2212 by 1659 pixels.
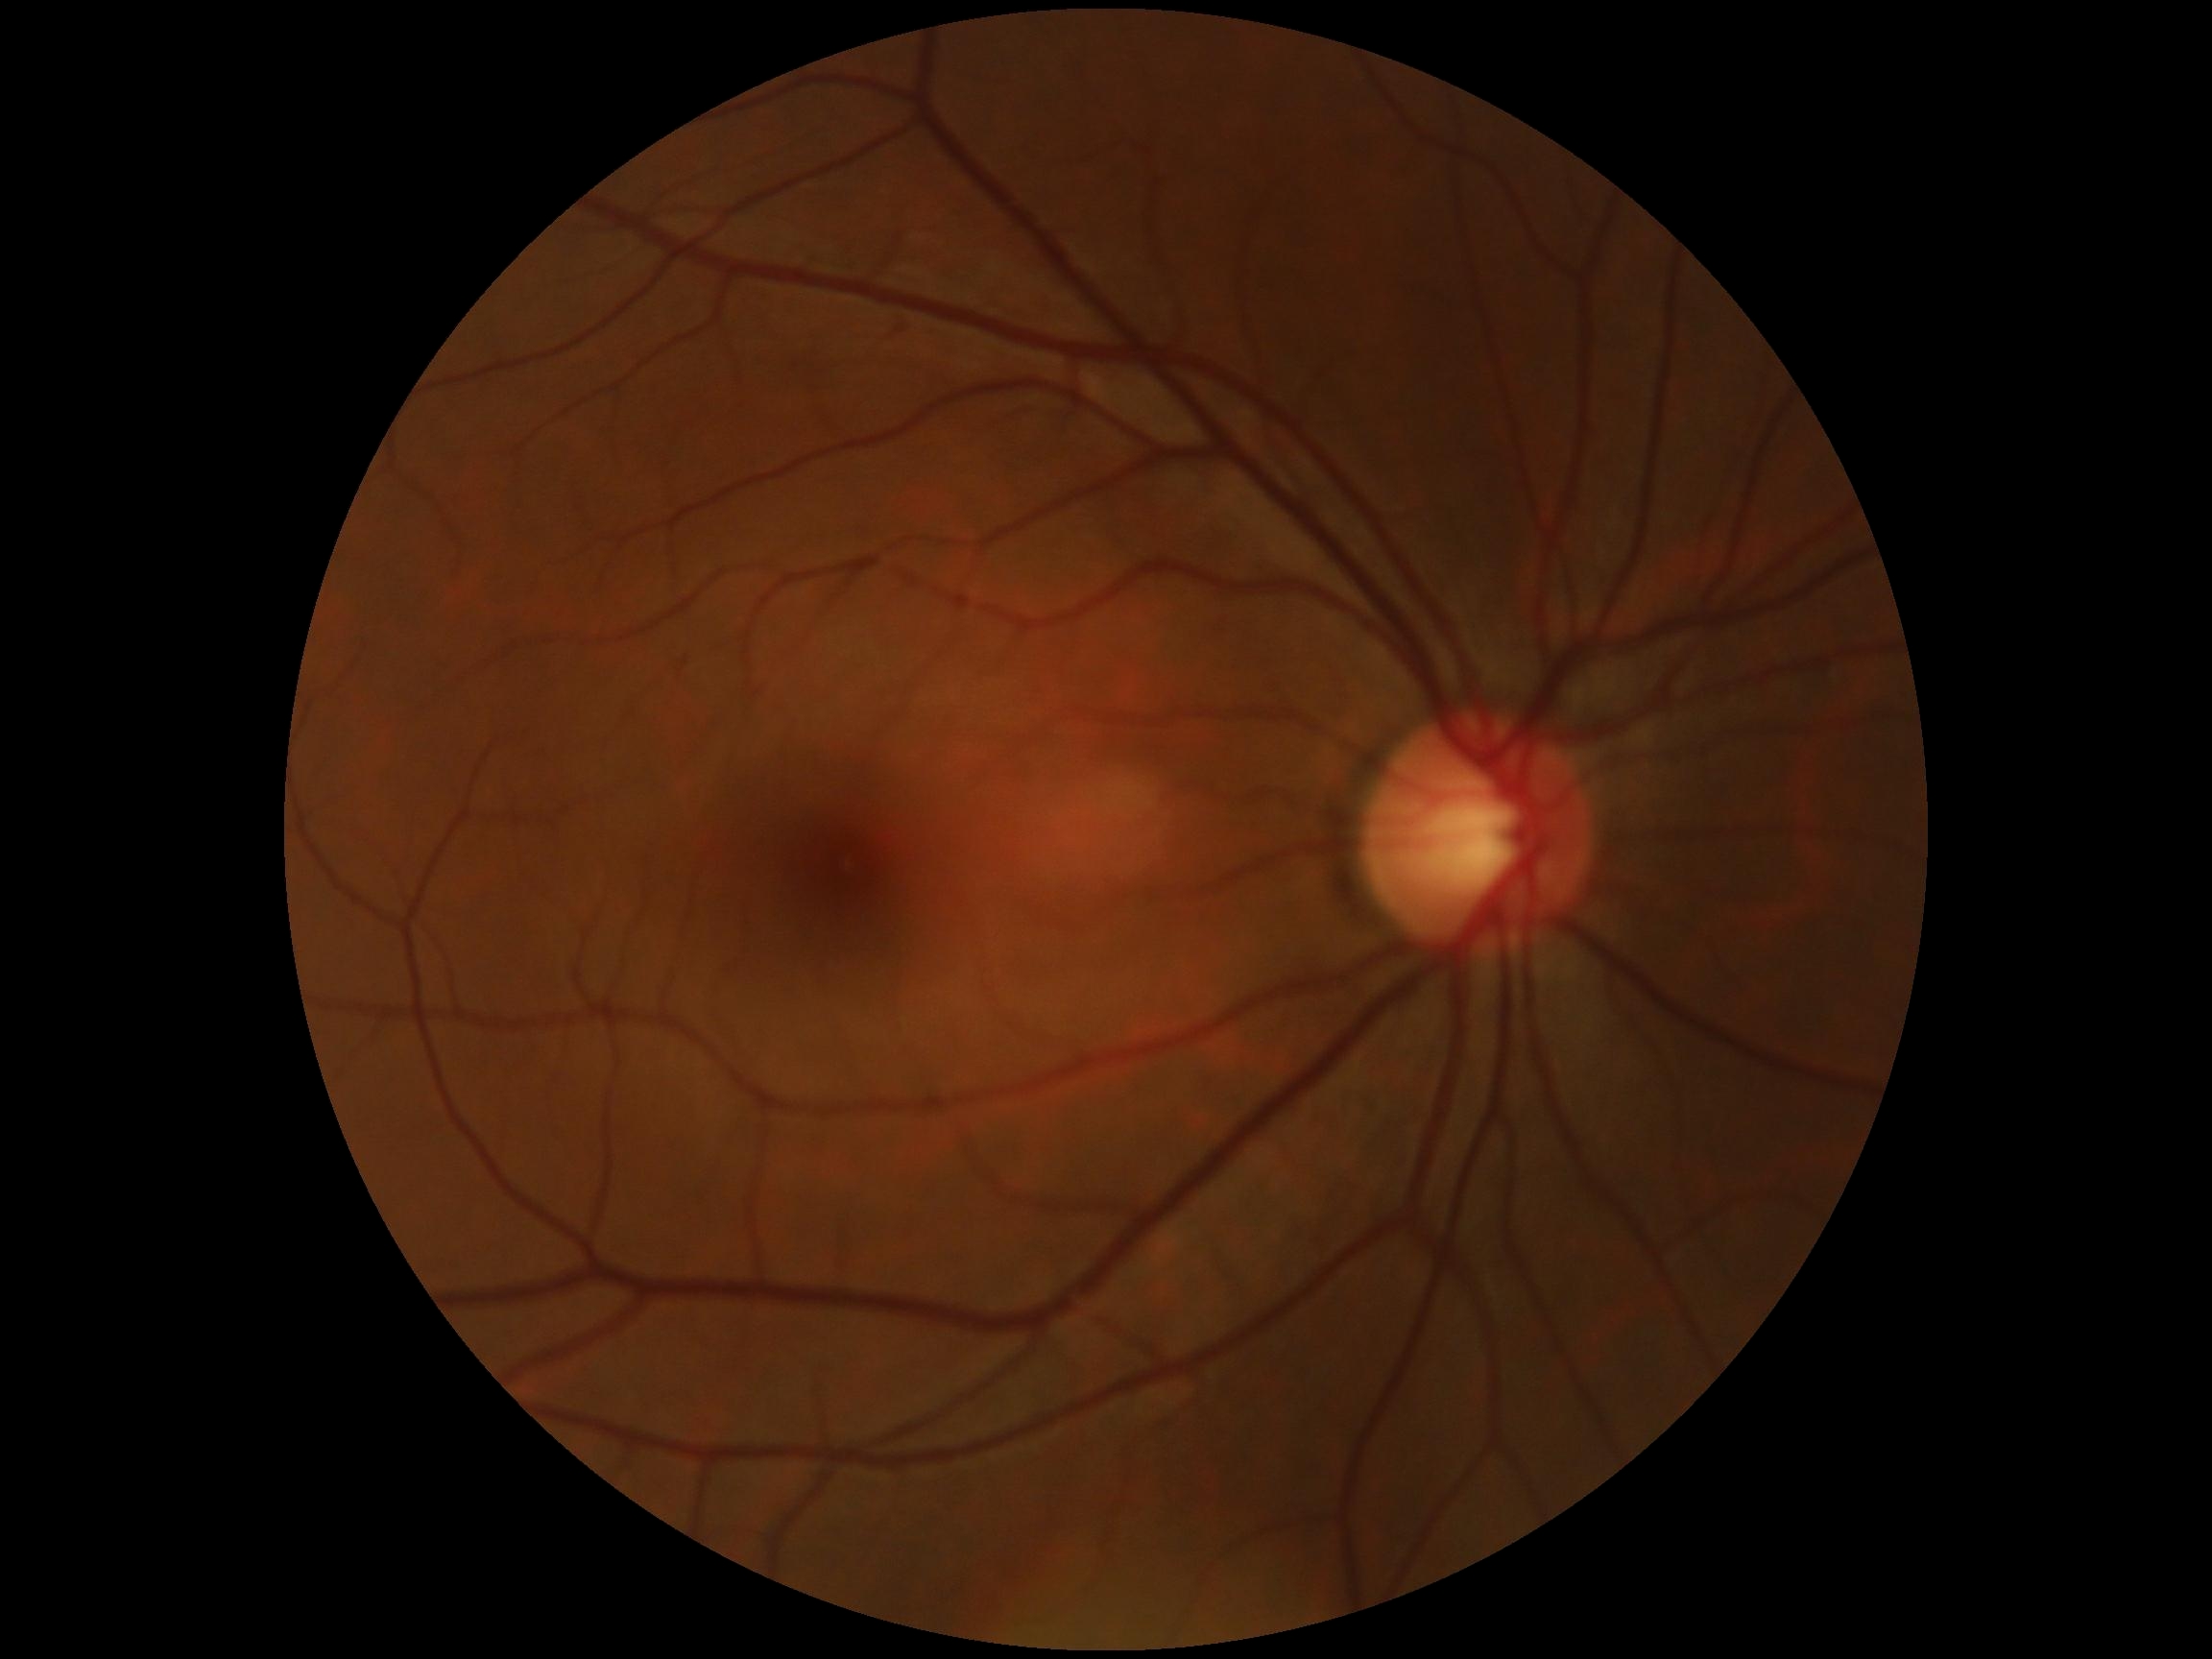

diabetic retinopathy (DR): no apparent retinopathy (grade 0) | DR impression: negative for DR.